Pediatric wide-field fundus photograph
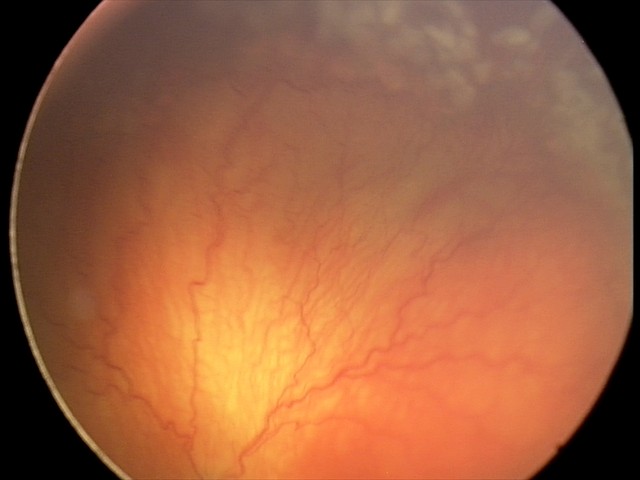
Diagnosis = aggressive retinopathy of prematurity (A-ROP), plus disease = present.